Infant wide-field retinal image. Camera: Natus RetCam Envision (130° FOV).
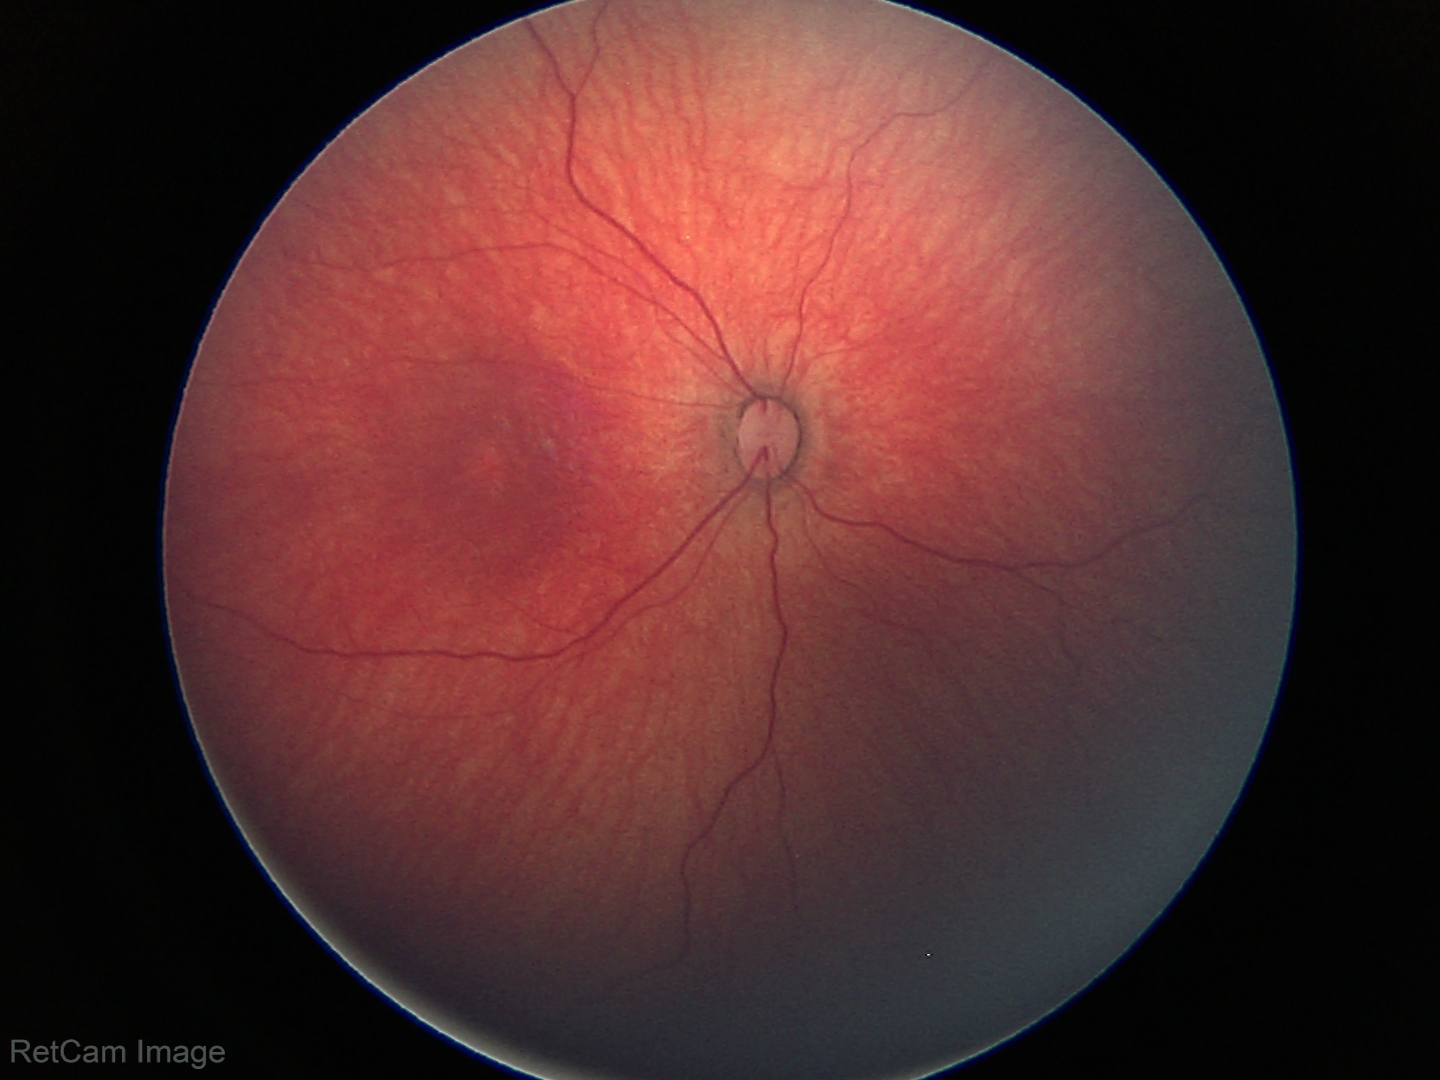

Q: What is the screening diagnosis?
A: normal retinal appearance